Retinal fundus photograph.
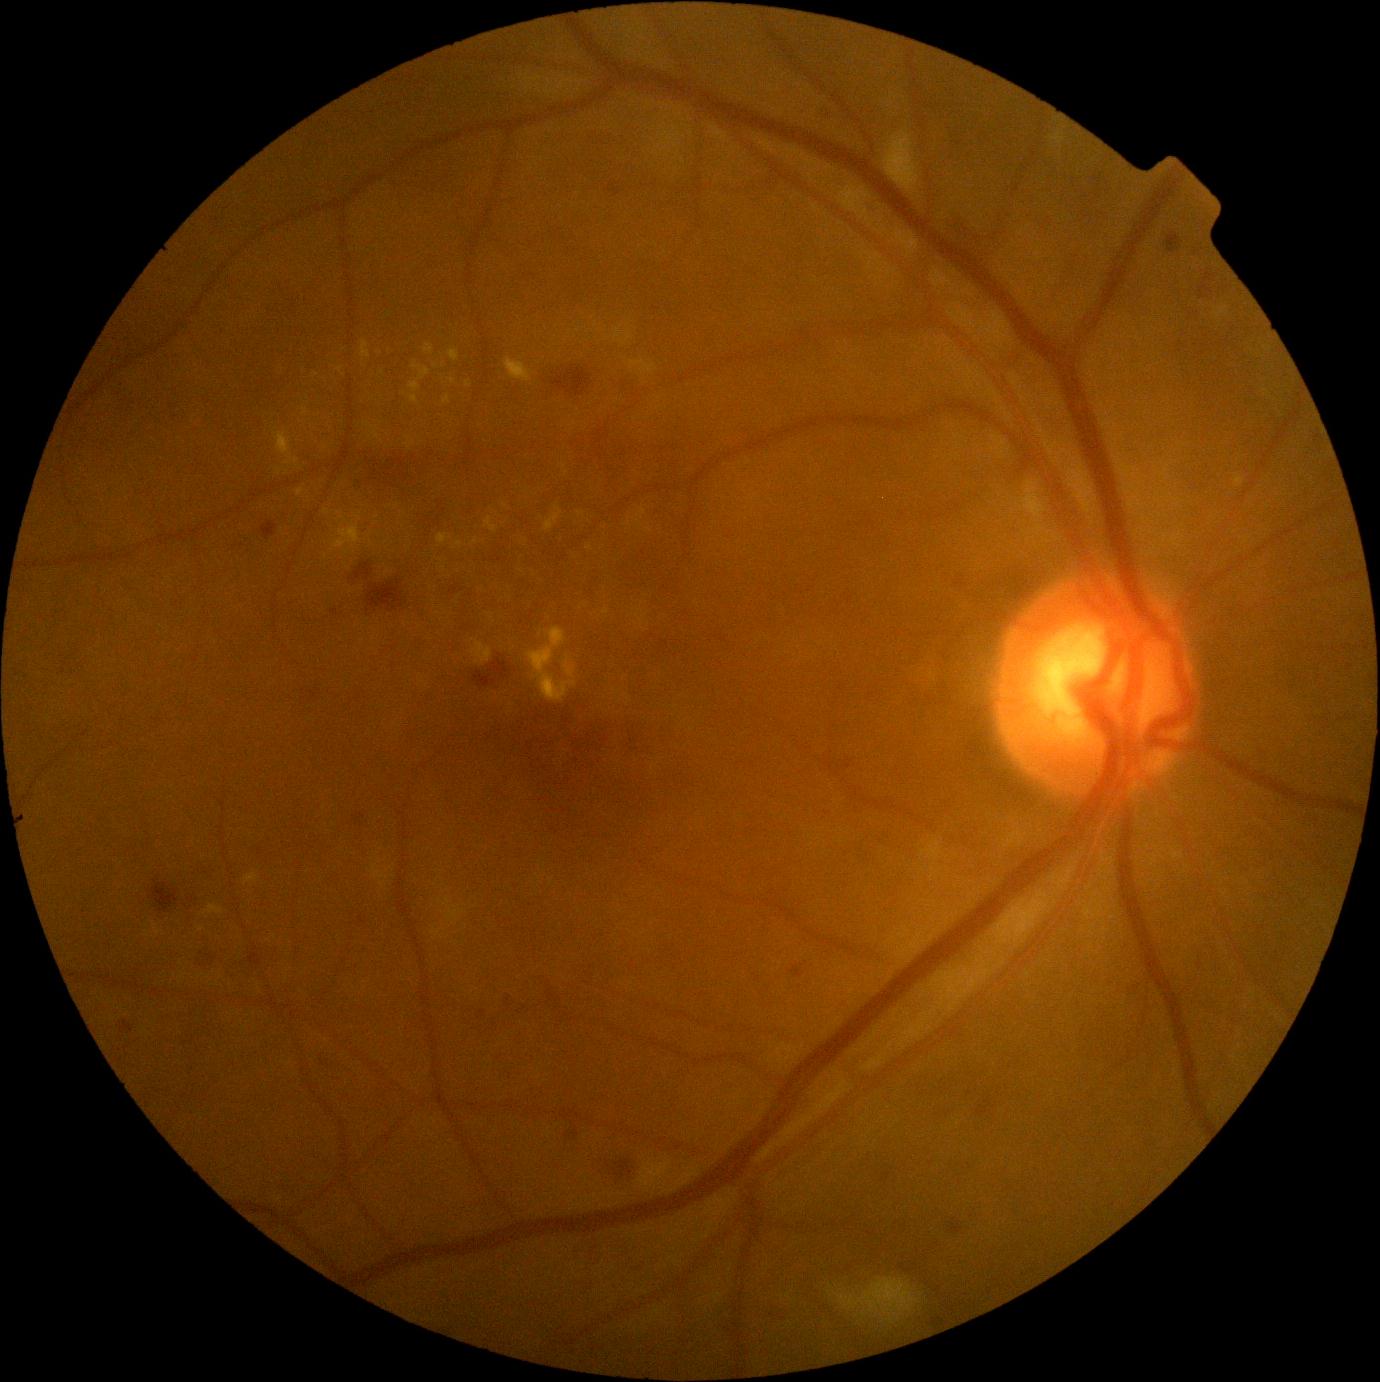

  dr_grade: grade 2 (moderate NPDR)